Diabetic retinopathy graded by the modified Davis classification:
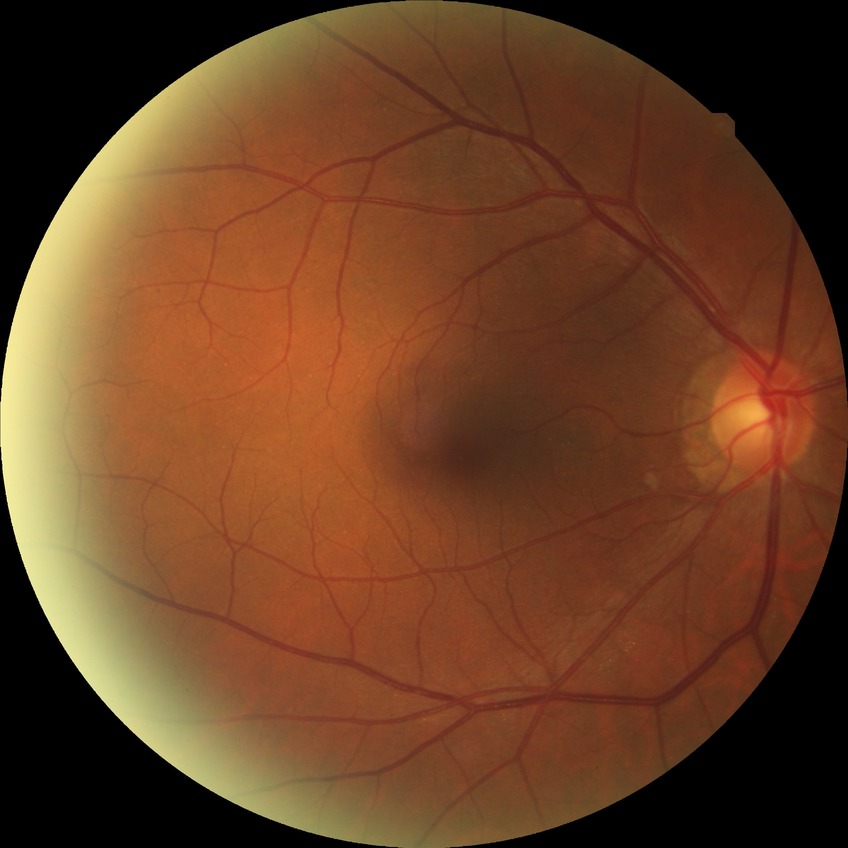
Diabetic retinopathy (DR) is NDR (no diabetic retinopathy).